Fundus photo, 2352x1568px, 45-degree field of view
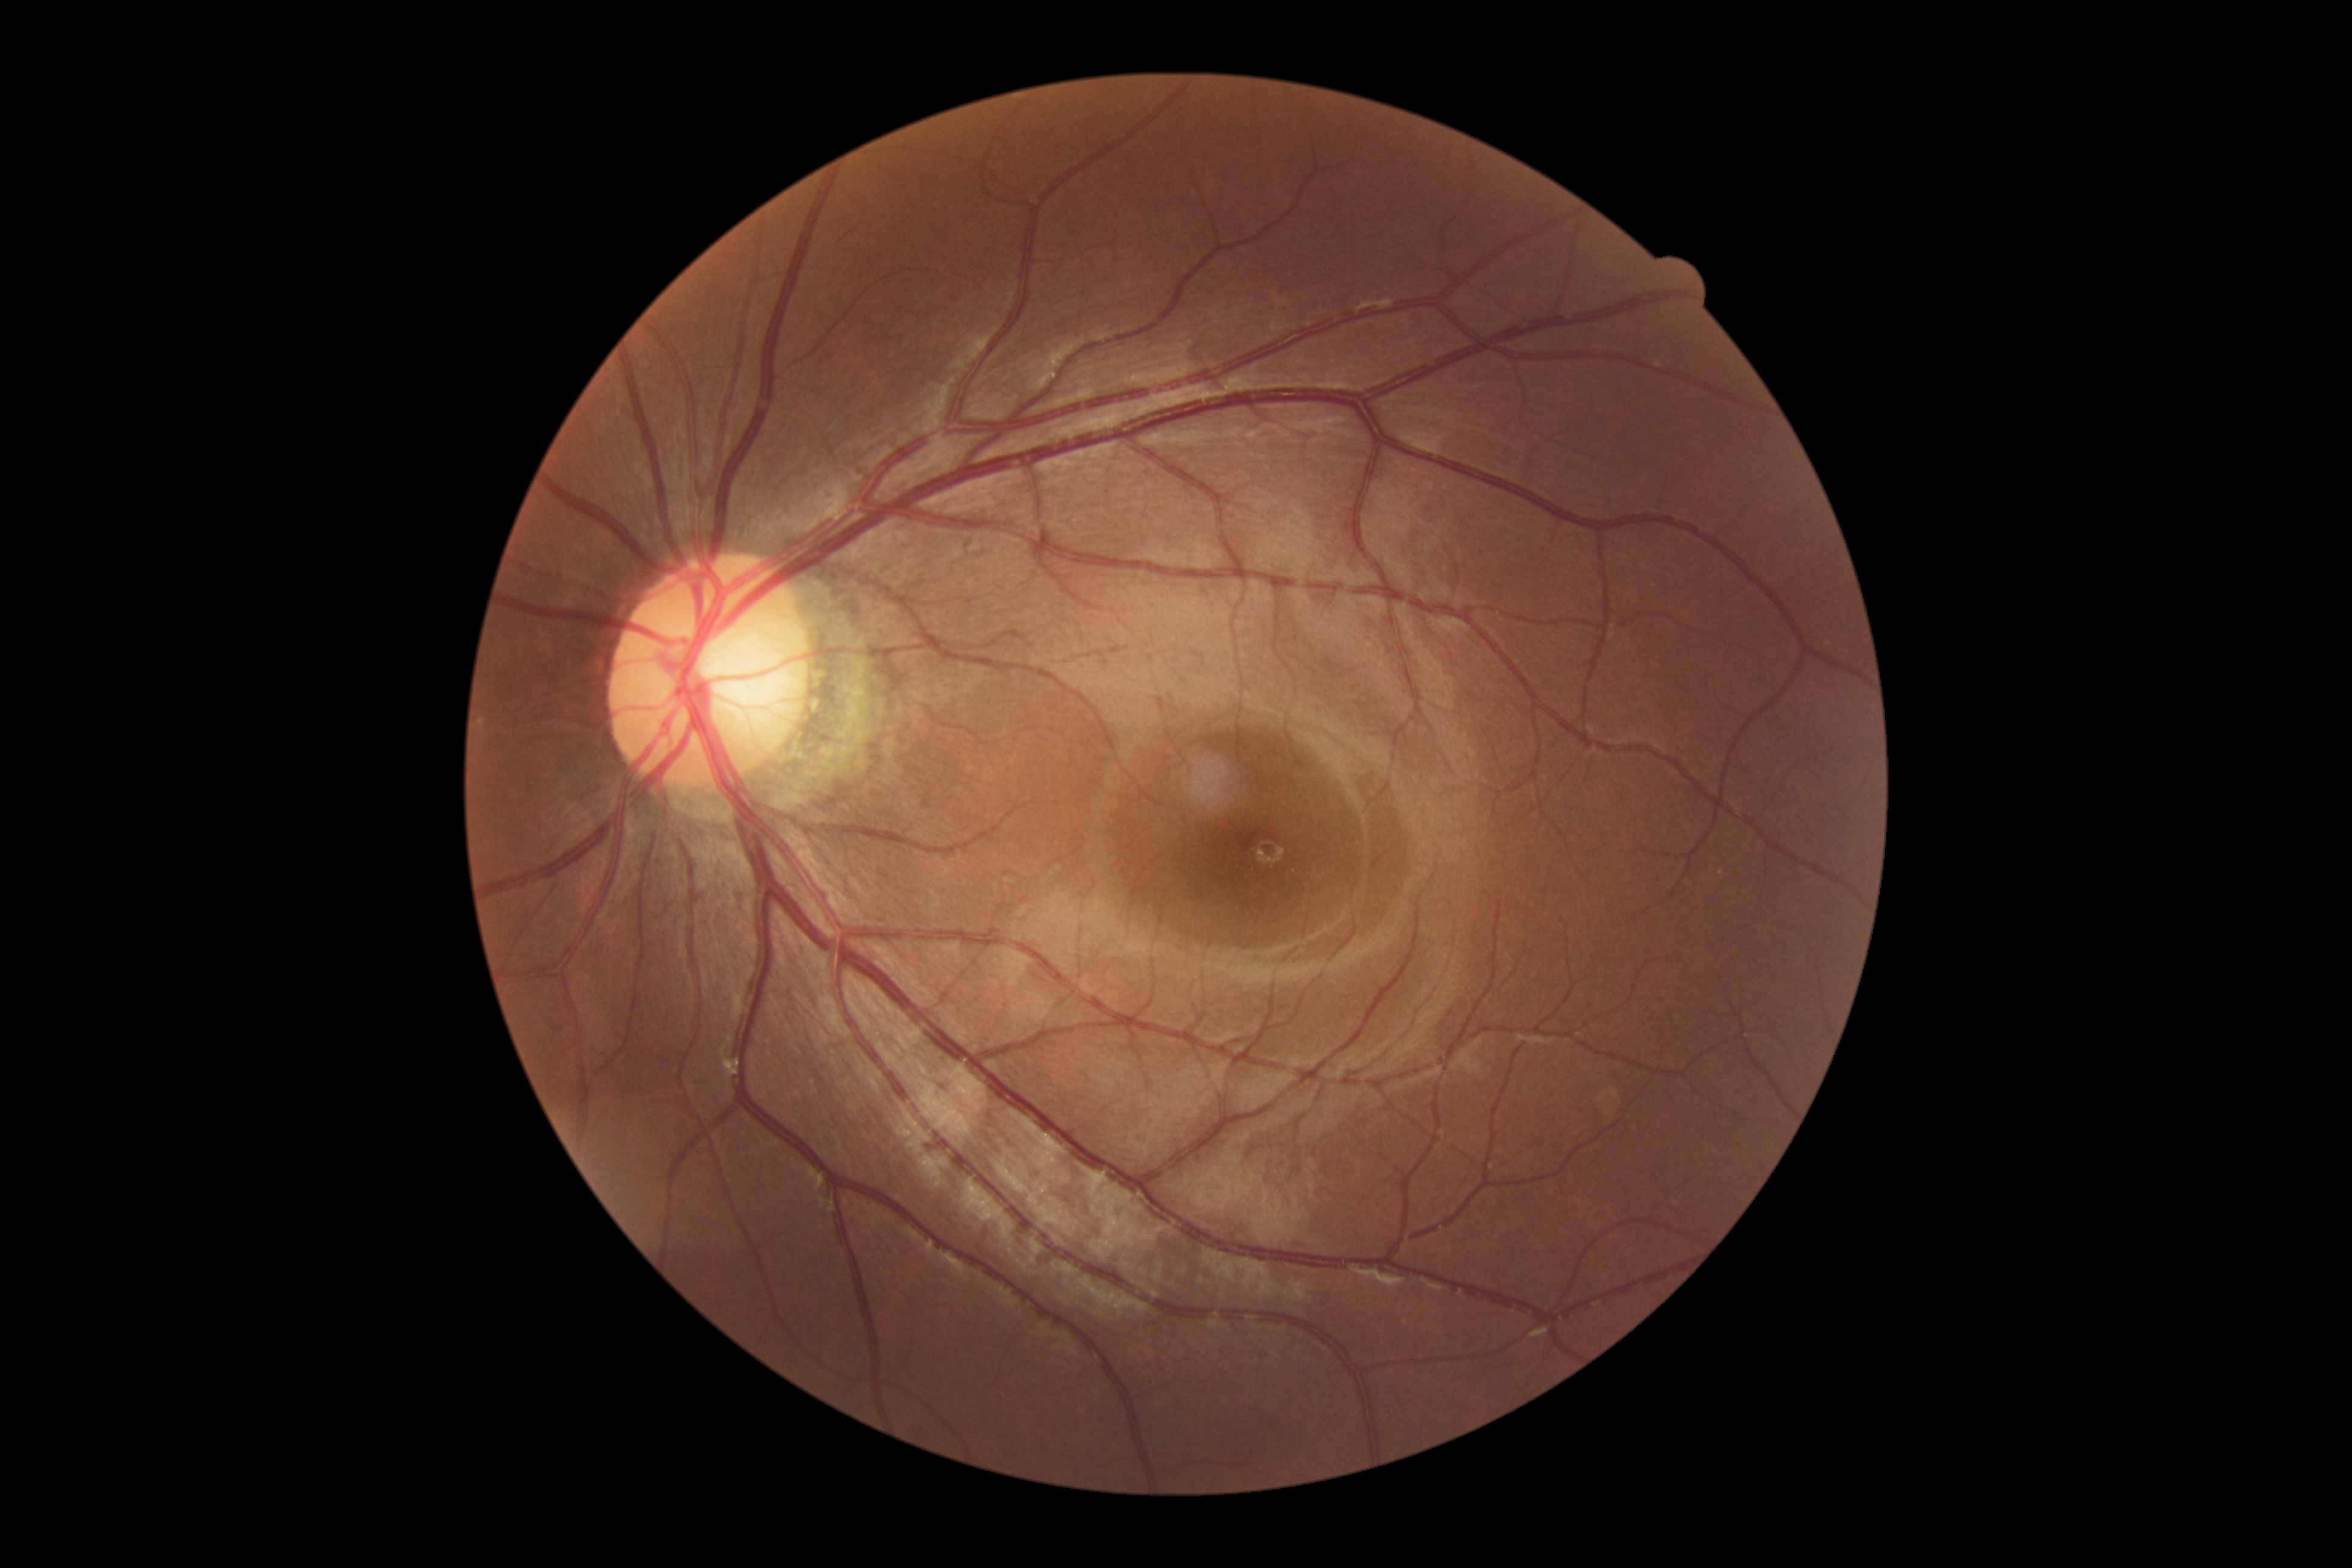

DR grade is 0.